45° field of view, fundus photo.
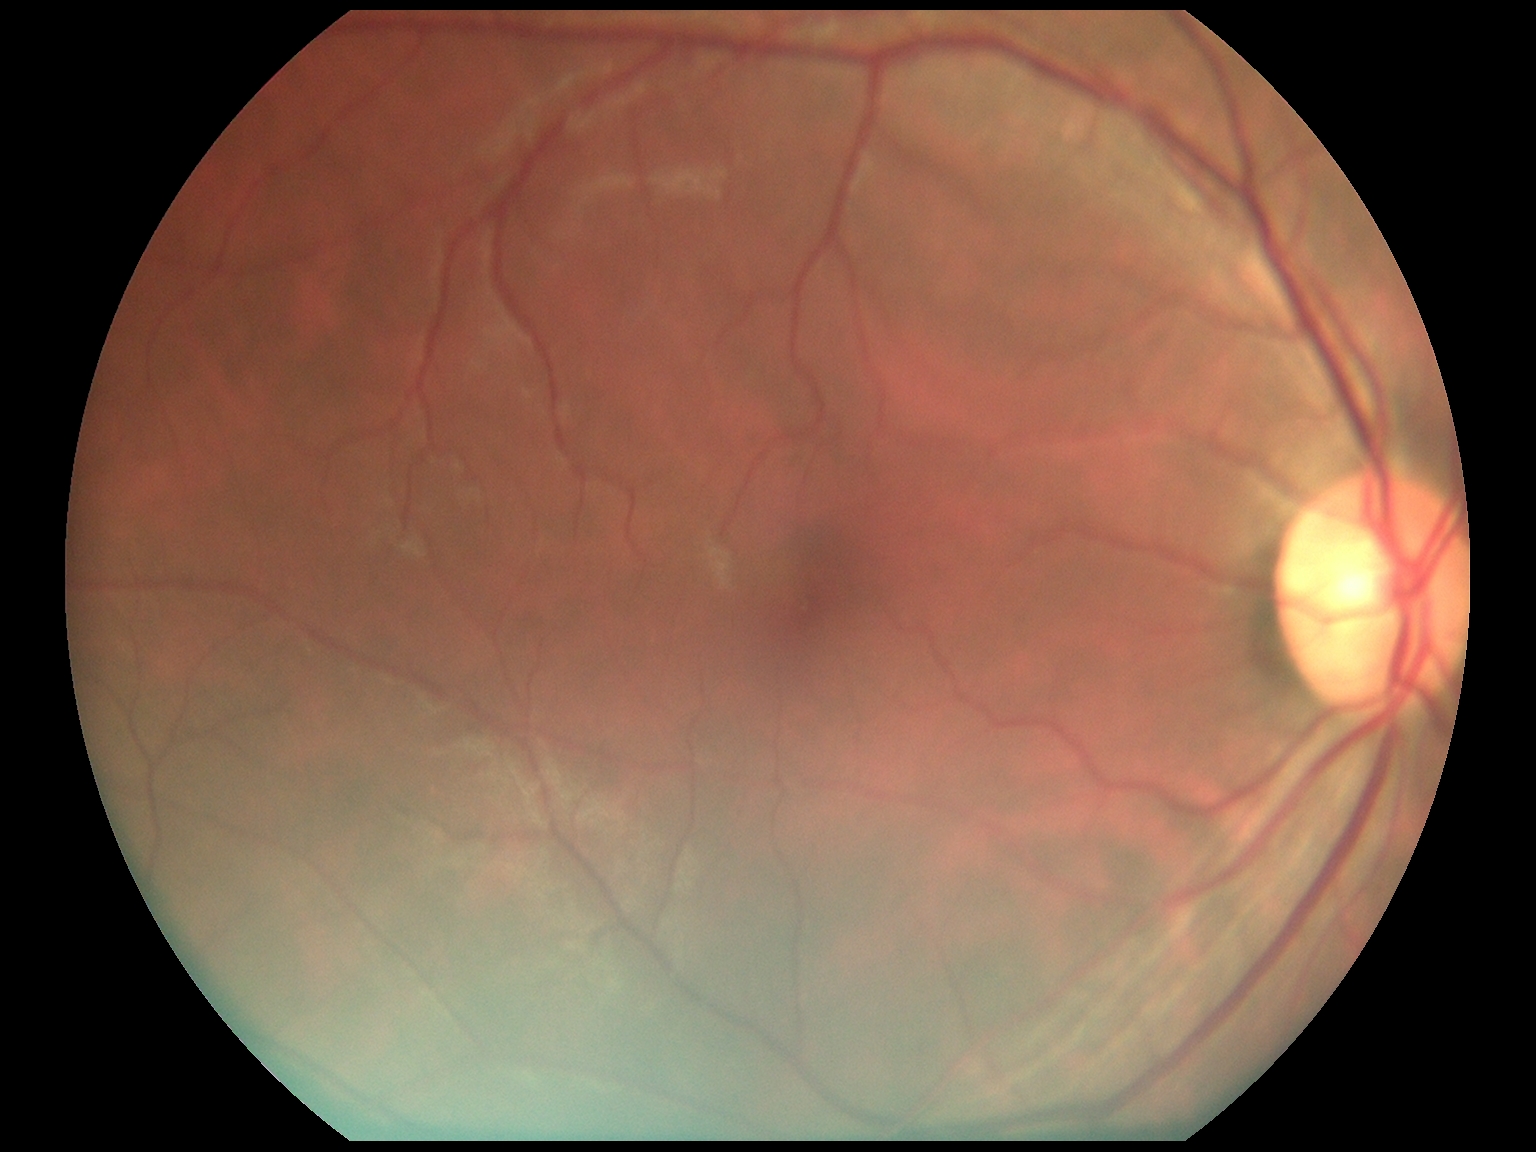

No signs of diabetic retinopathy.
Diabetic retinopathy is grade 0 (no apparent retinopathy) — no visible signs of diabetic retinopathy.